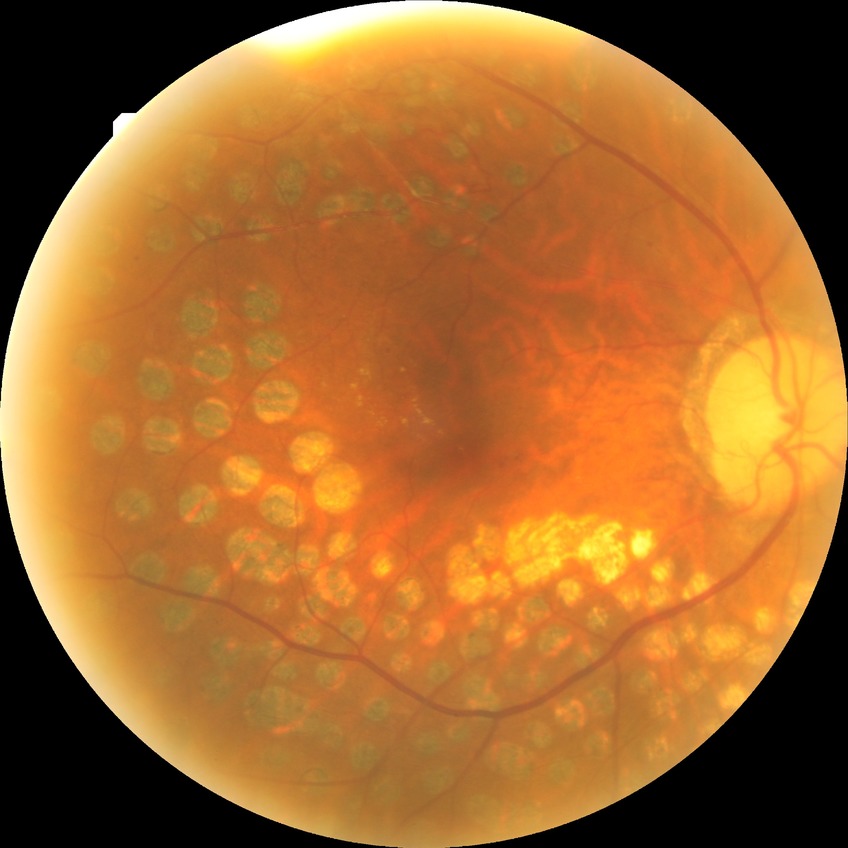
modified Davis grading = proliferative diabetic retinopathy.